2352x1568 — 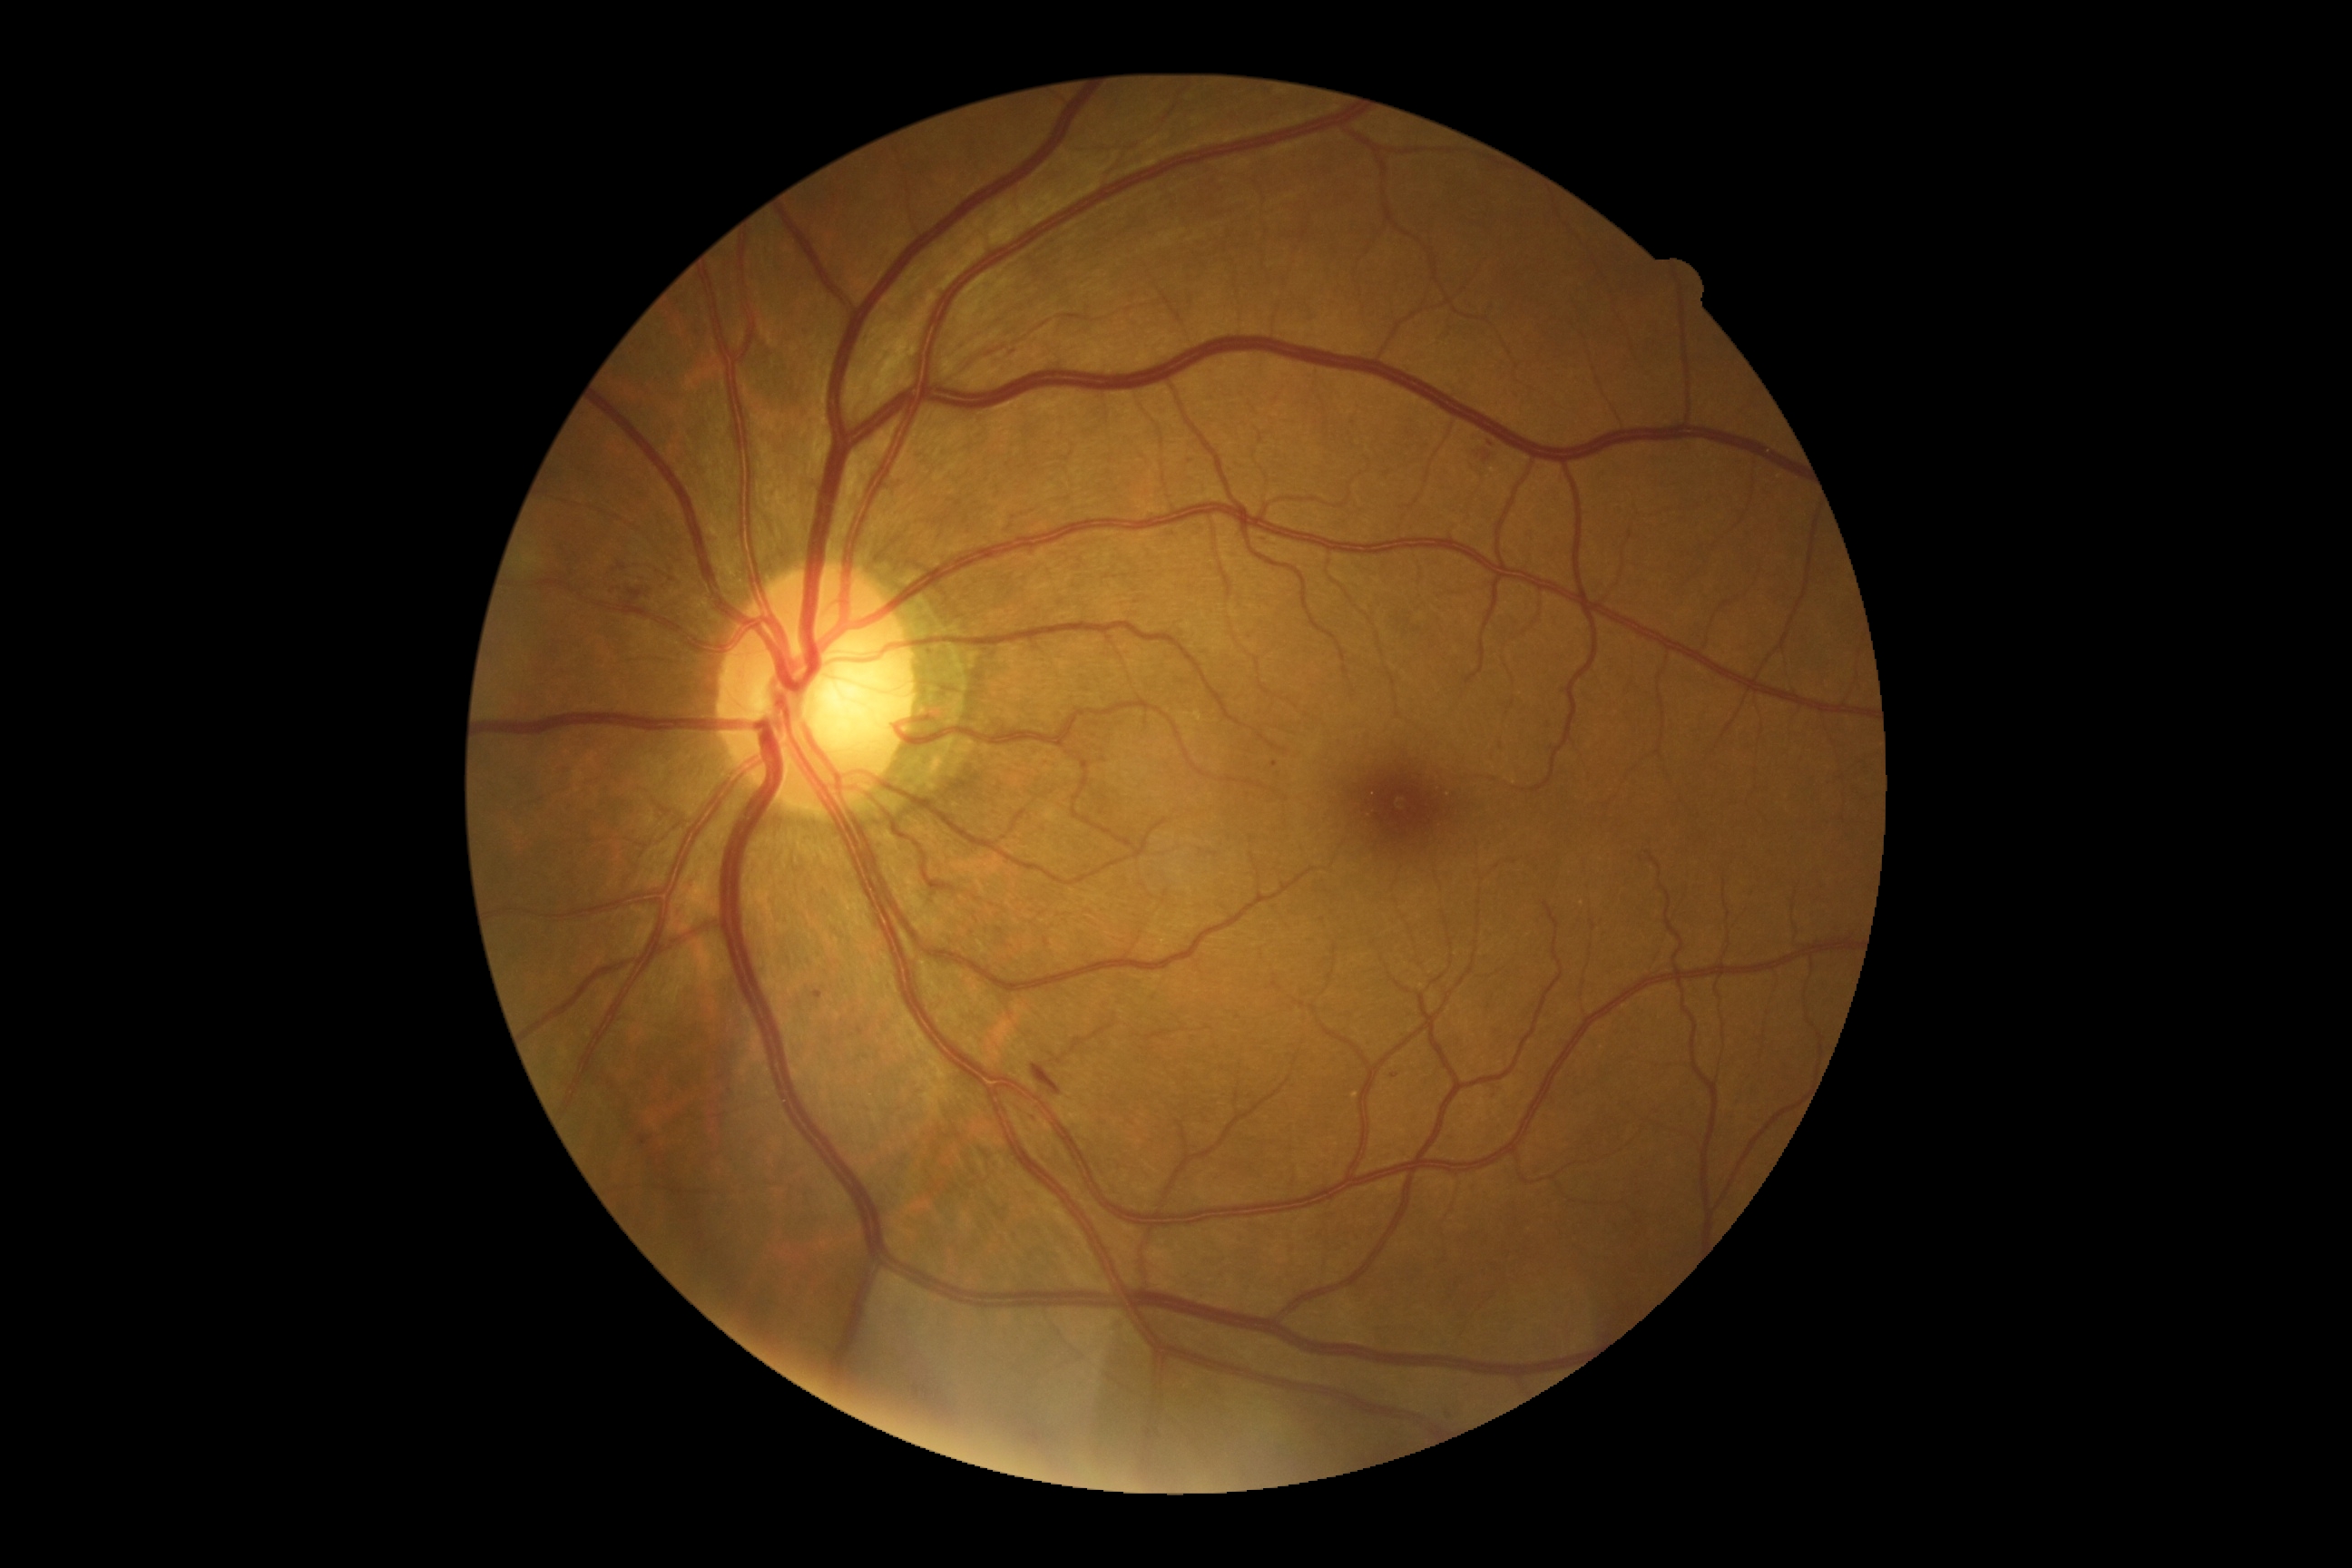

DR stage: grade 2 (moderate NPDR).